Acquired on the Phoenix ICON · wide-field fundus photograph of an infant · image size 1240x1240
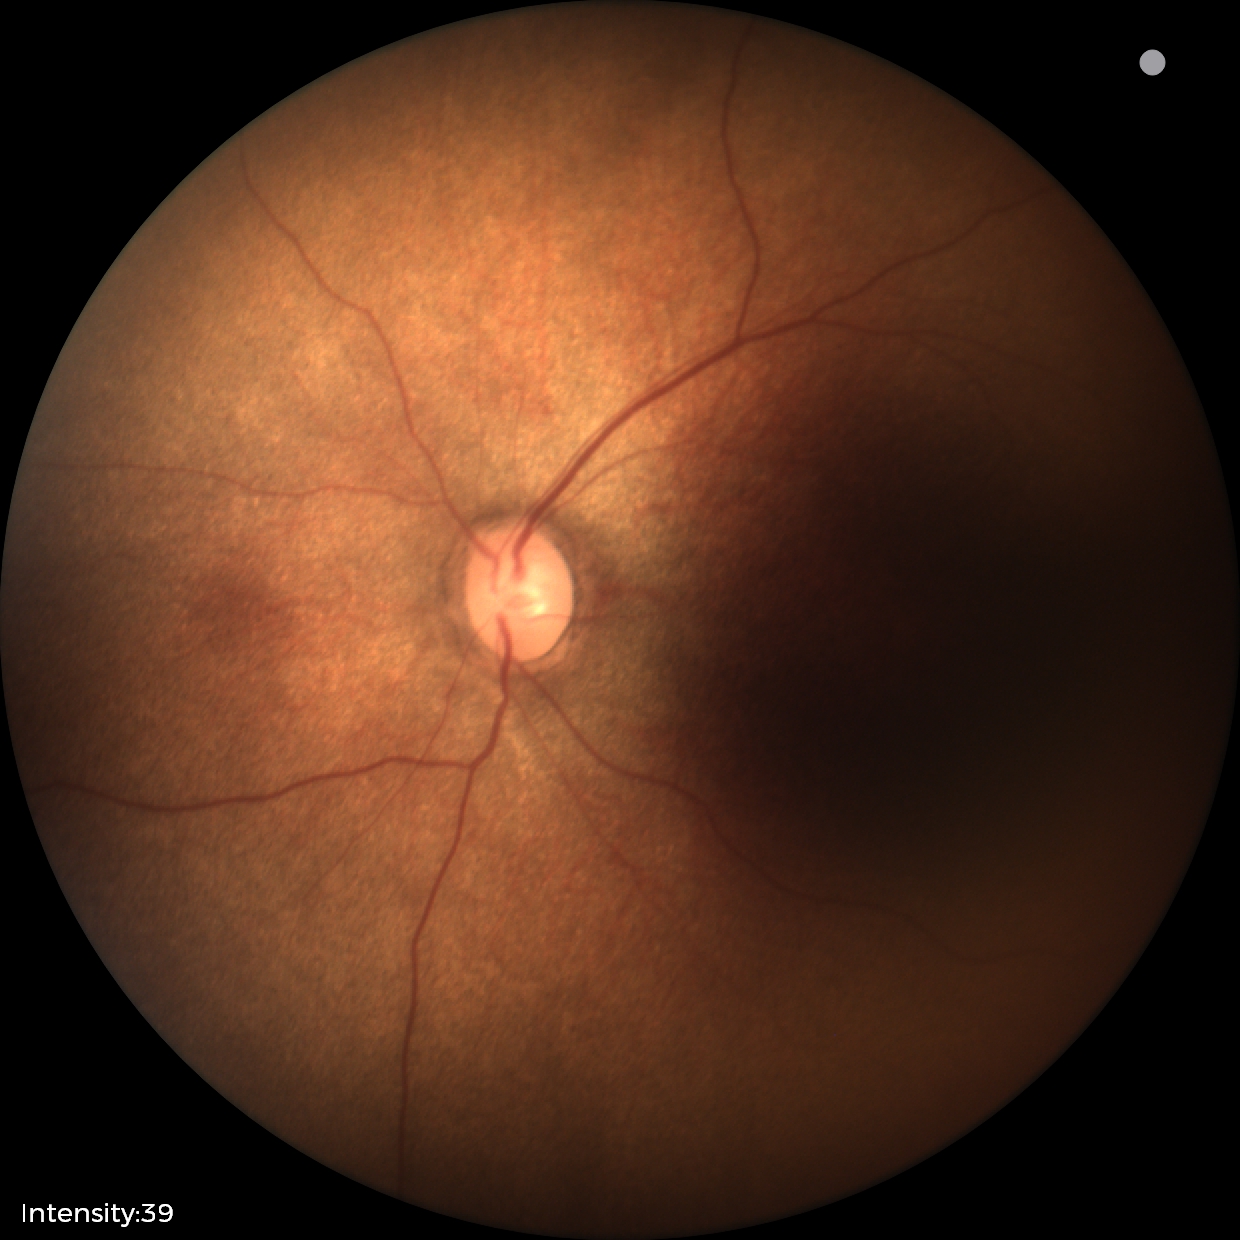

Screening examination diagnosed as physiological.